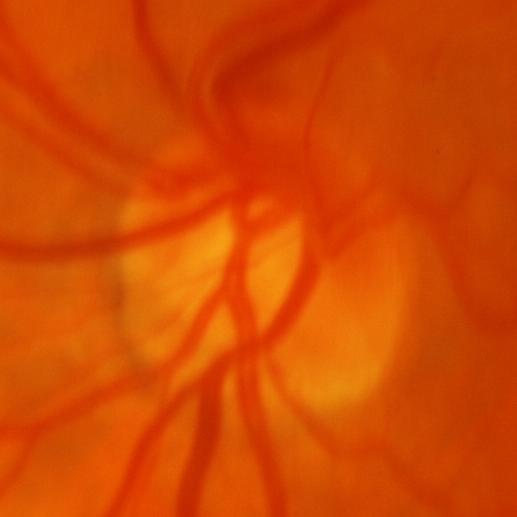
Glaucoma diagnosis = evidence of glaucoma.